Without pupil dilation · 45 degree fundus photograph · NIDEK AFC-230 fundus camera · modified Davis classification · 848x848.
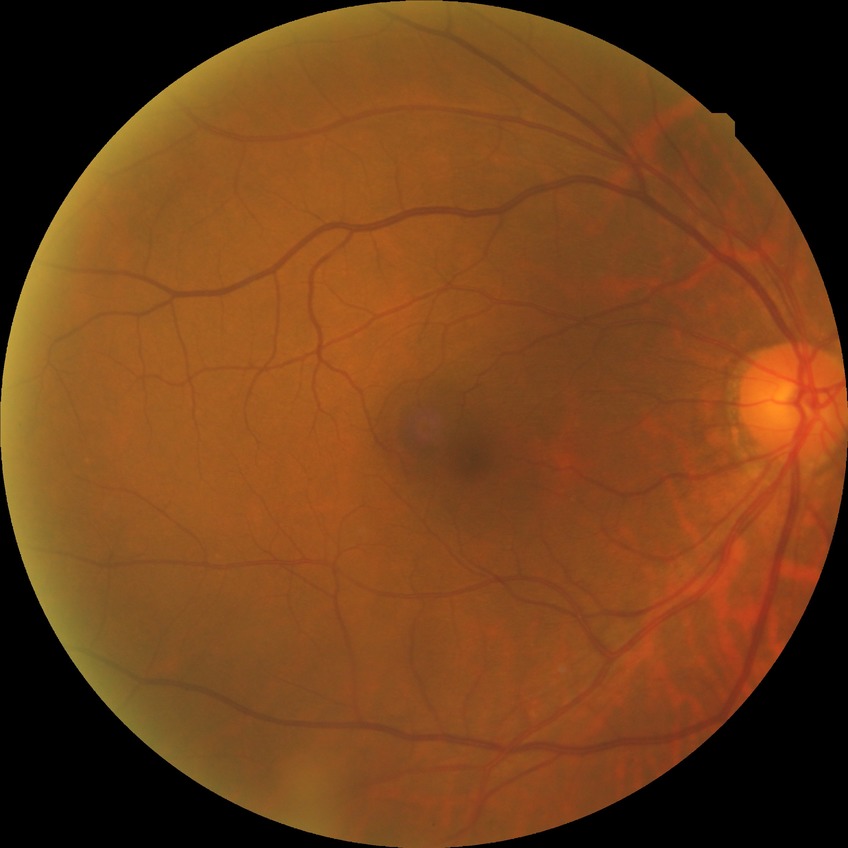

Diabetic retinopathy (DR) is no diabetic retinopathy (NDR).